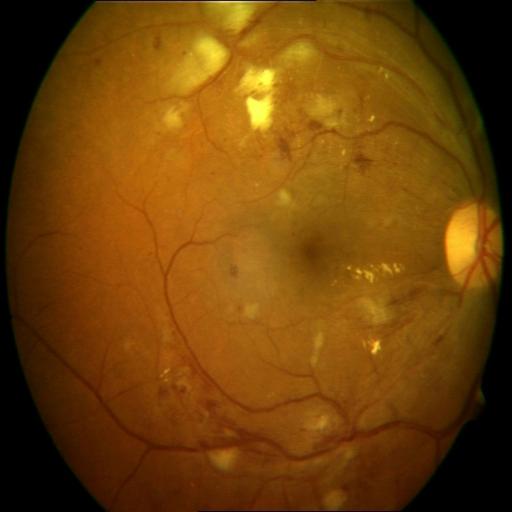
Diagnosis (3):
- EDN (exudation)
- HR (hemorrhagic retinopathy)
- CWS (cotton wool spots)